Fundus photo, 2102 by 1736 pixels
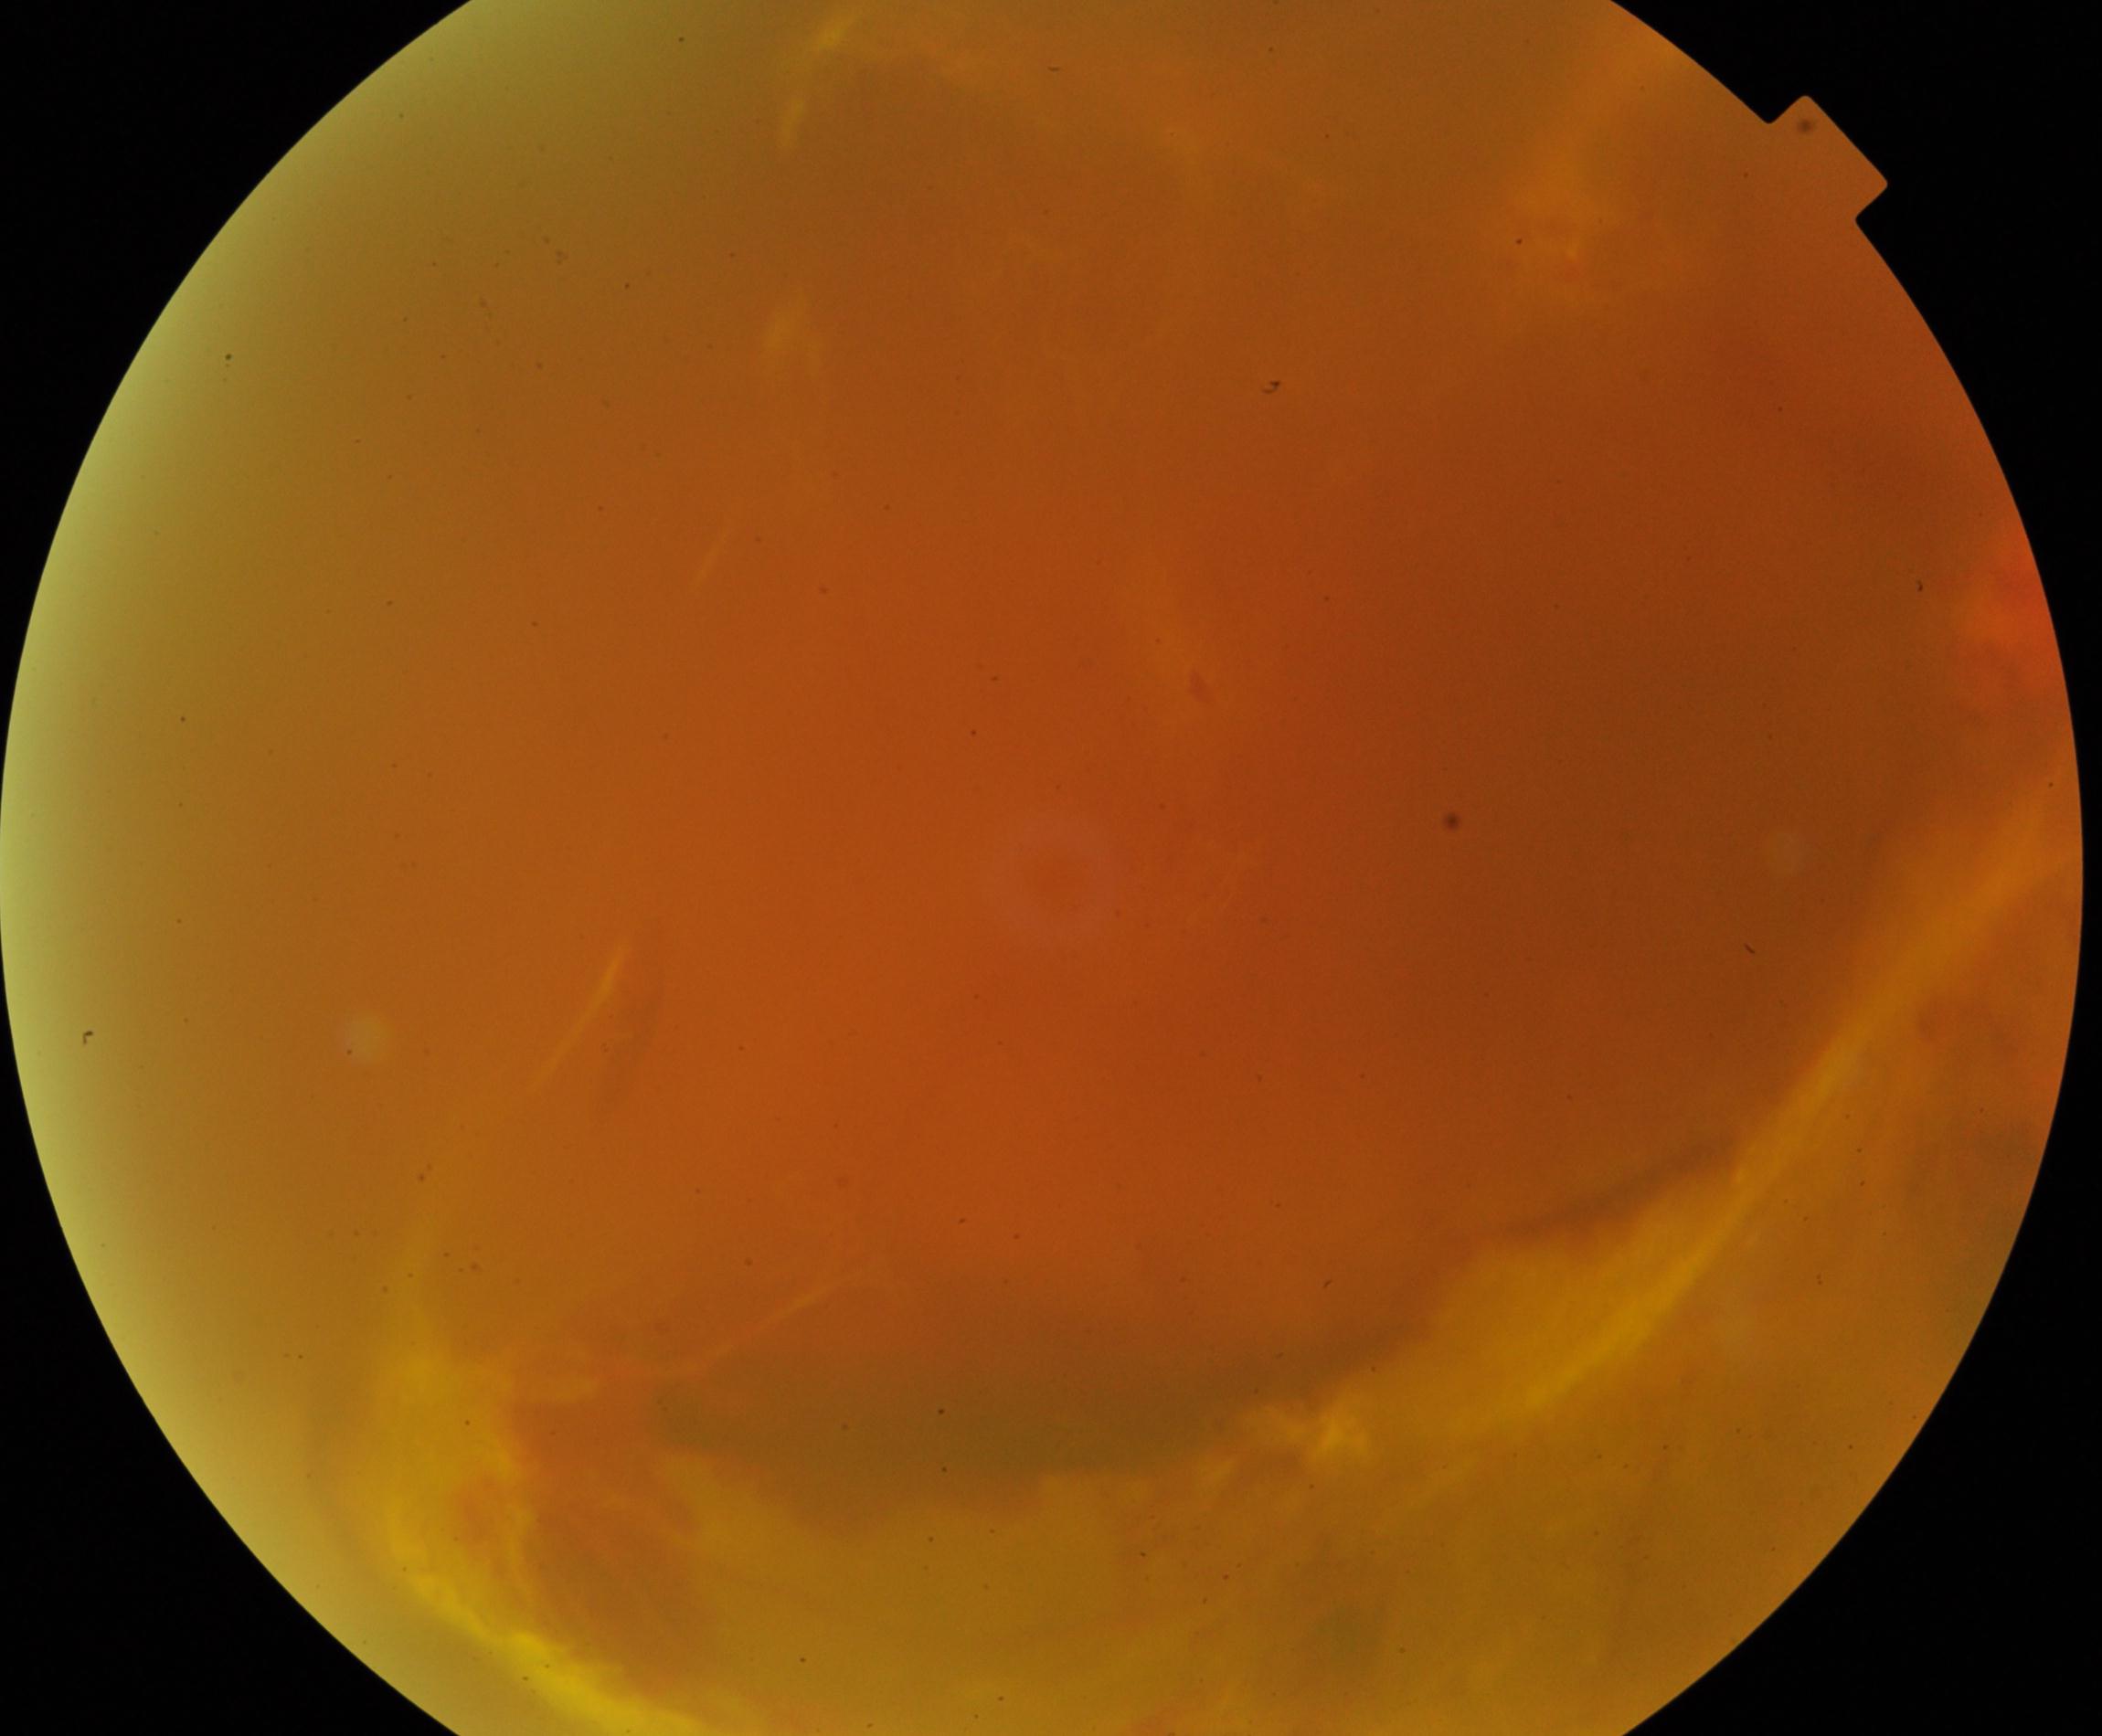

Significantly degraded image quality with obscured retinal detail. Features suspicious for proliferative diabetic retinopathy.